Nonmydriatic — 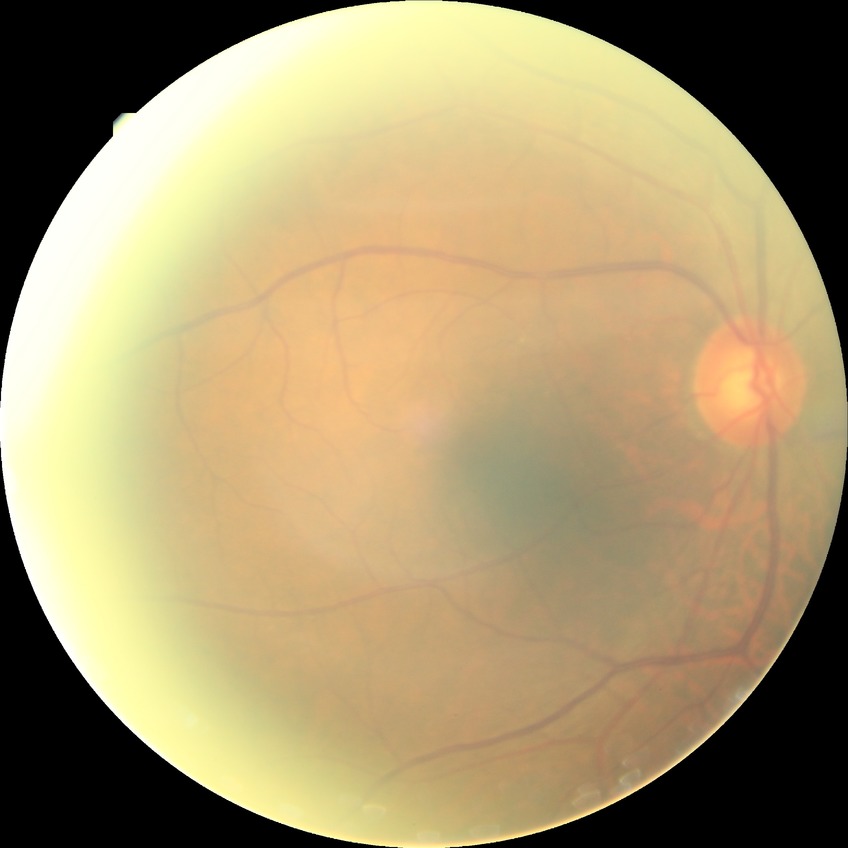

modified Davis grading = no diabetic retinopathy.